2352 x 1568 pixels: 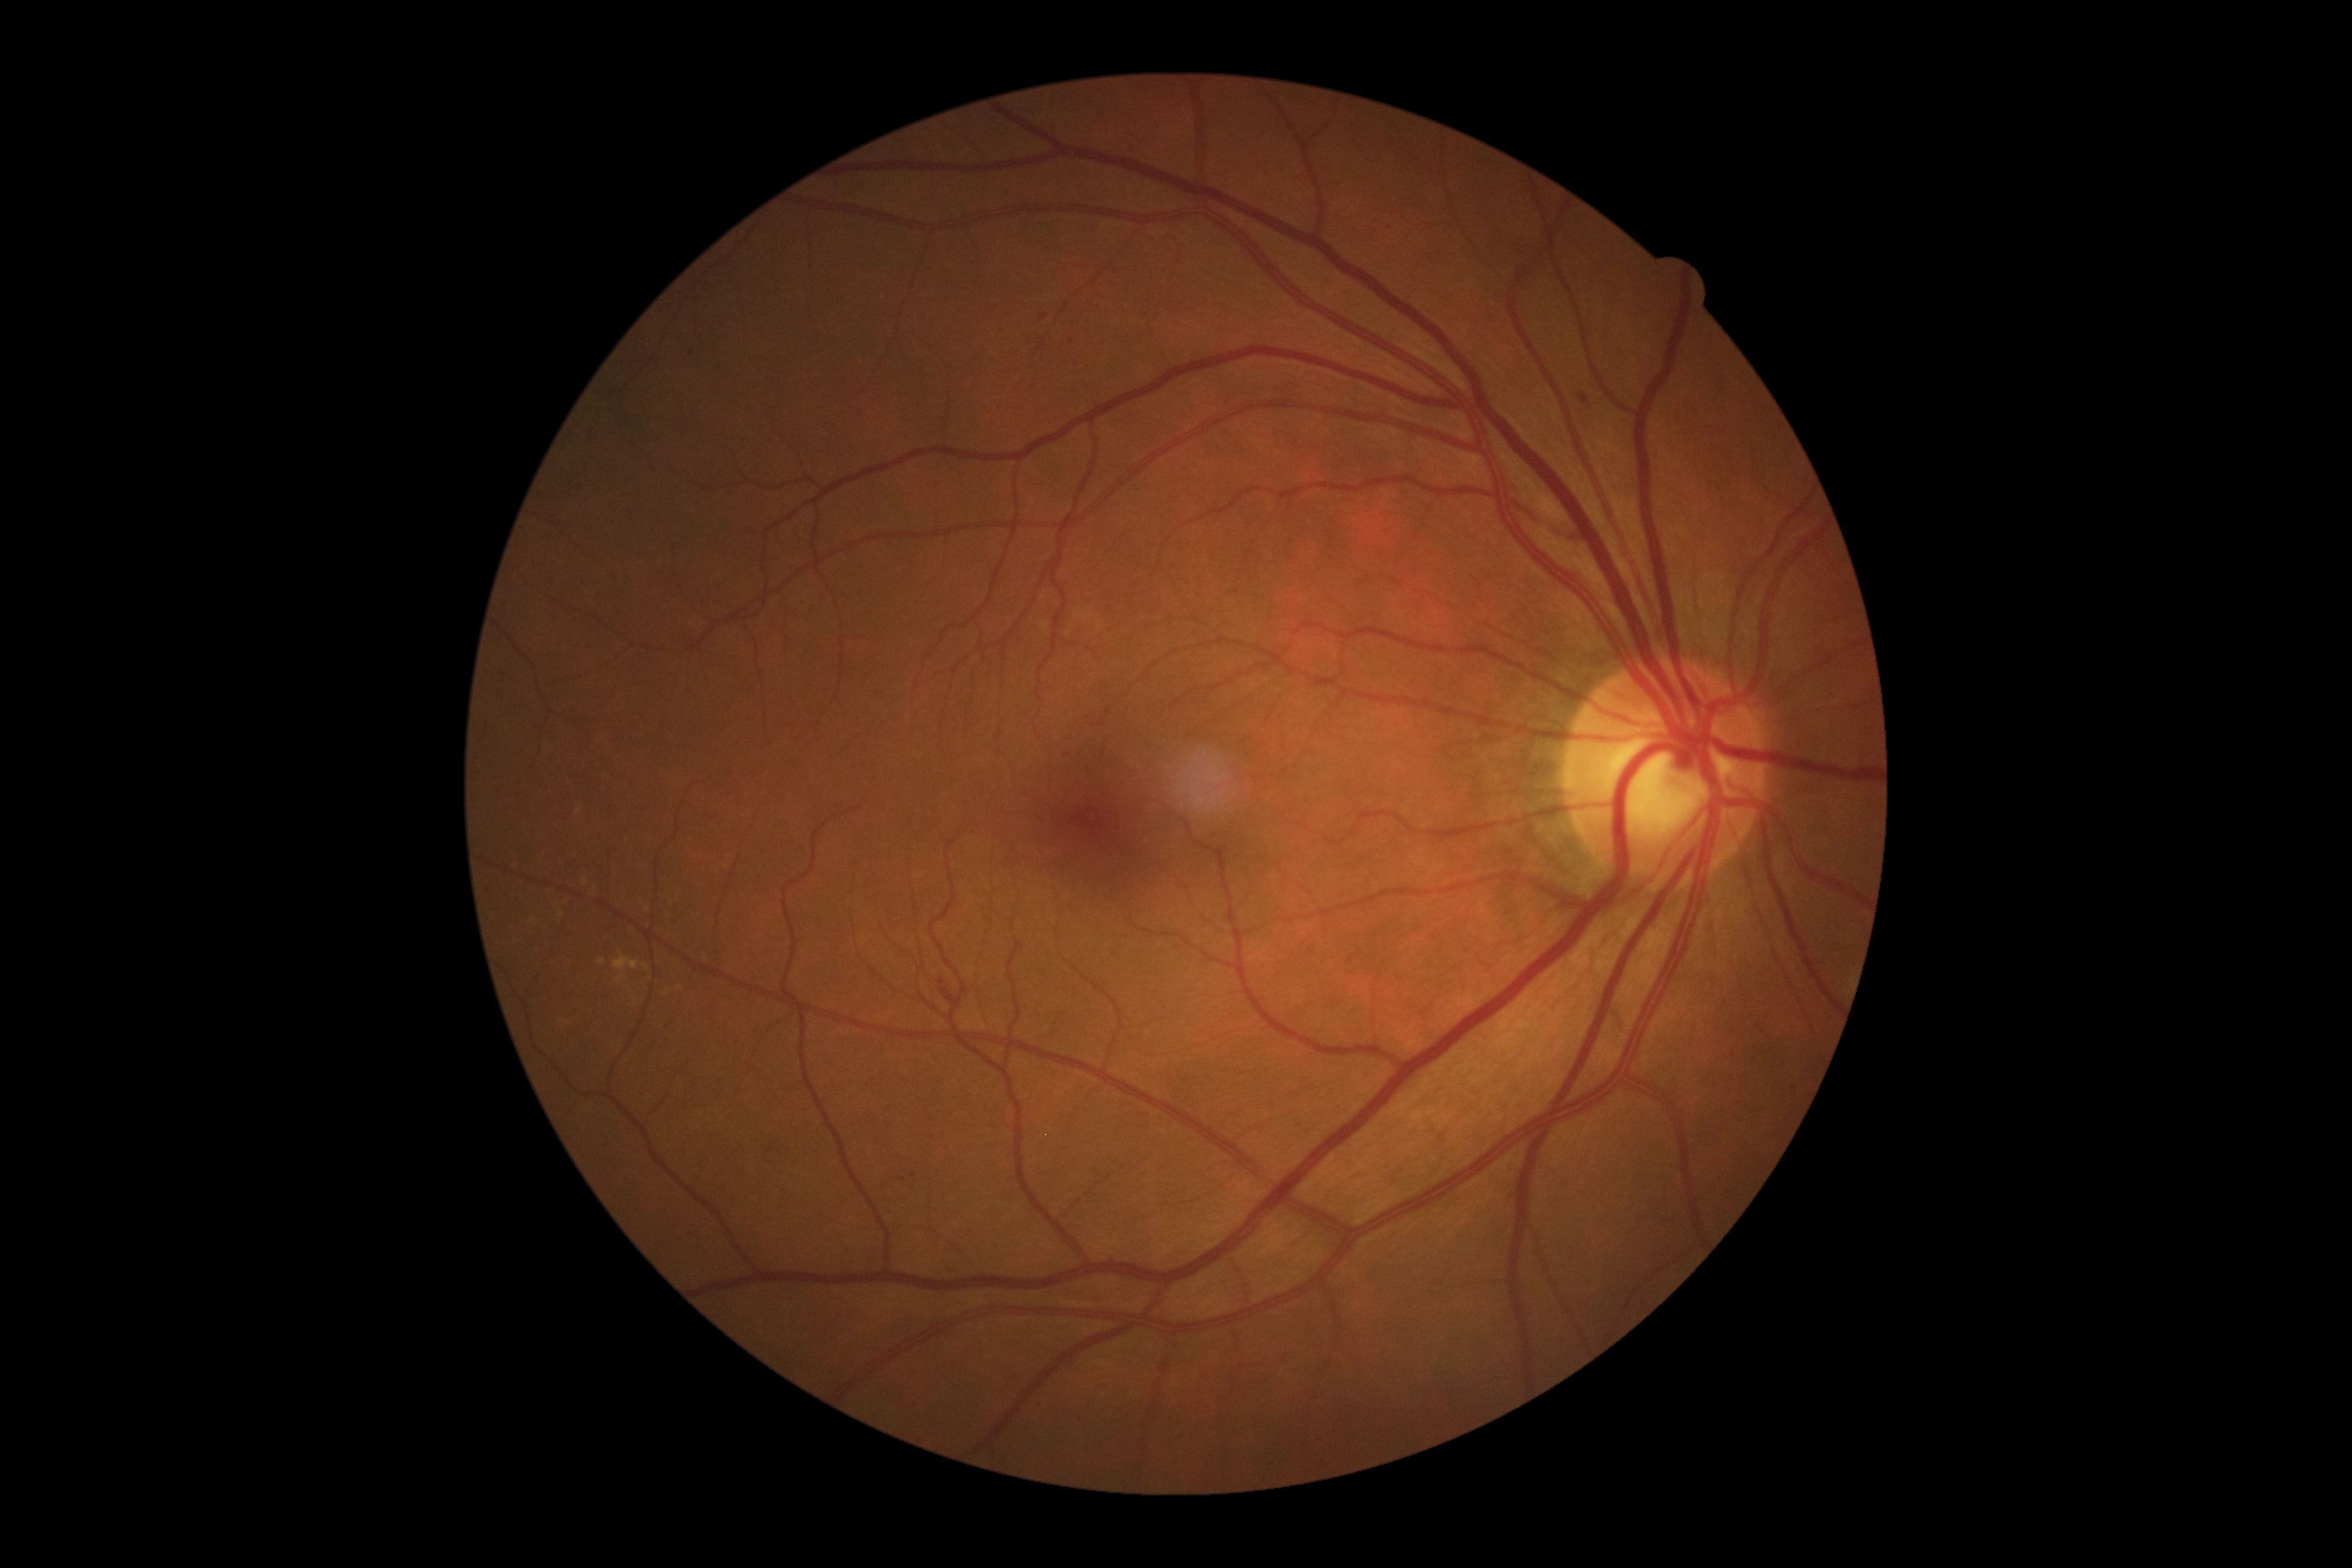
dr_grade: 2
lesions:
  se: []
  ma:
    - [left=1579, top=394, right=1589, bottom=405]
    - [left=1273, top=1356, right=1285, bottom=1363]
  ma_small_approx:
    - (903; 1179)
    - (1044; 317)
    - (1072; 341)
    - (581; 488)
    - (915; 1175)
  ex: []
  he:
    - [left=939, top=979, right=956, bottom=1006]